Retinal fundus photograph:
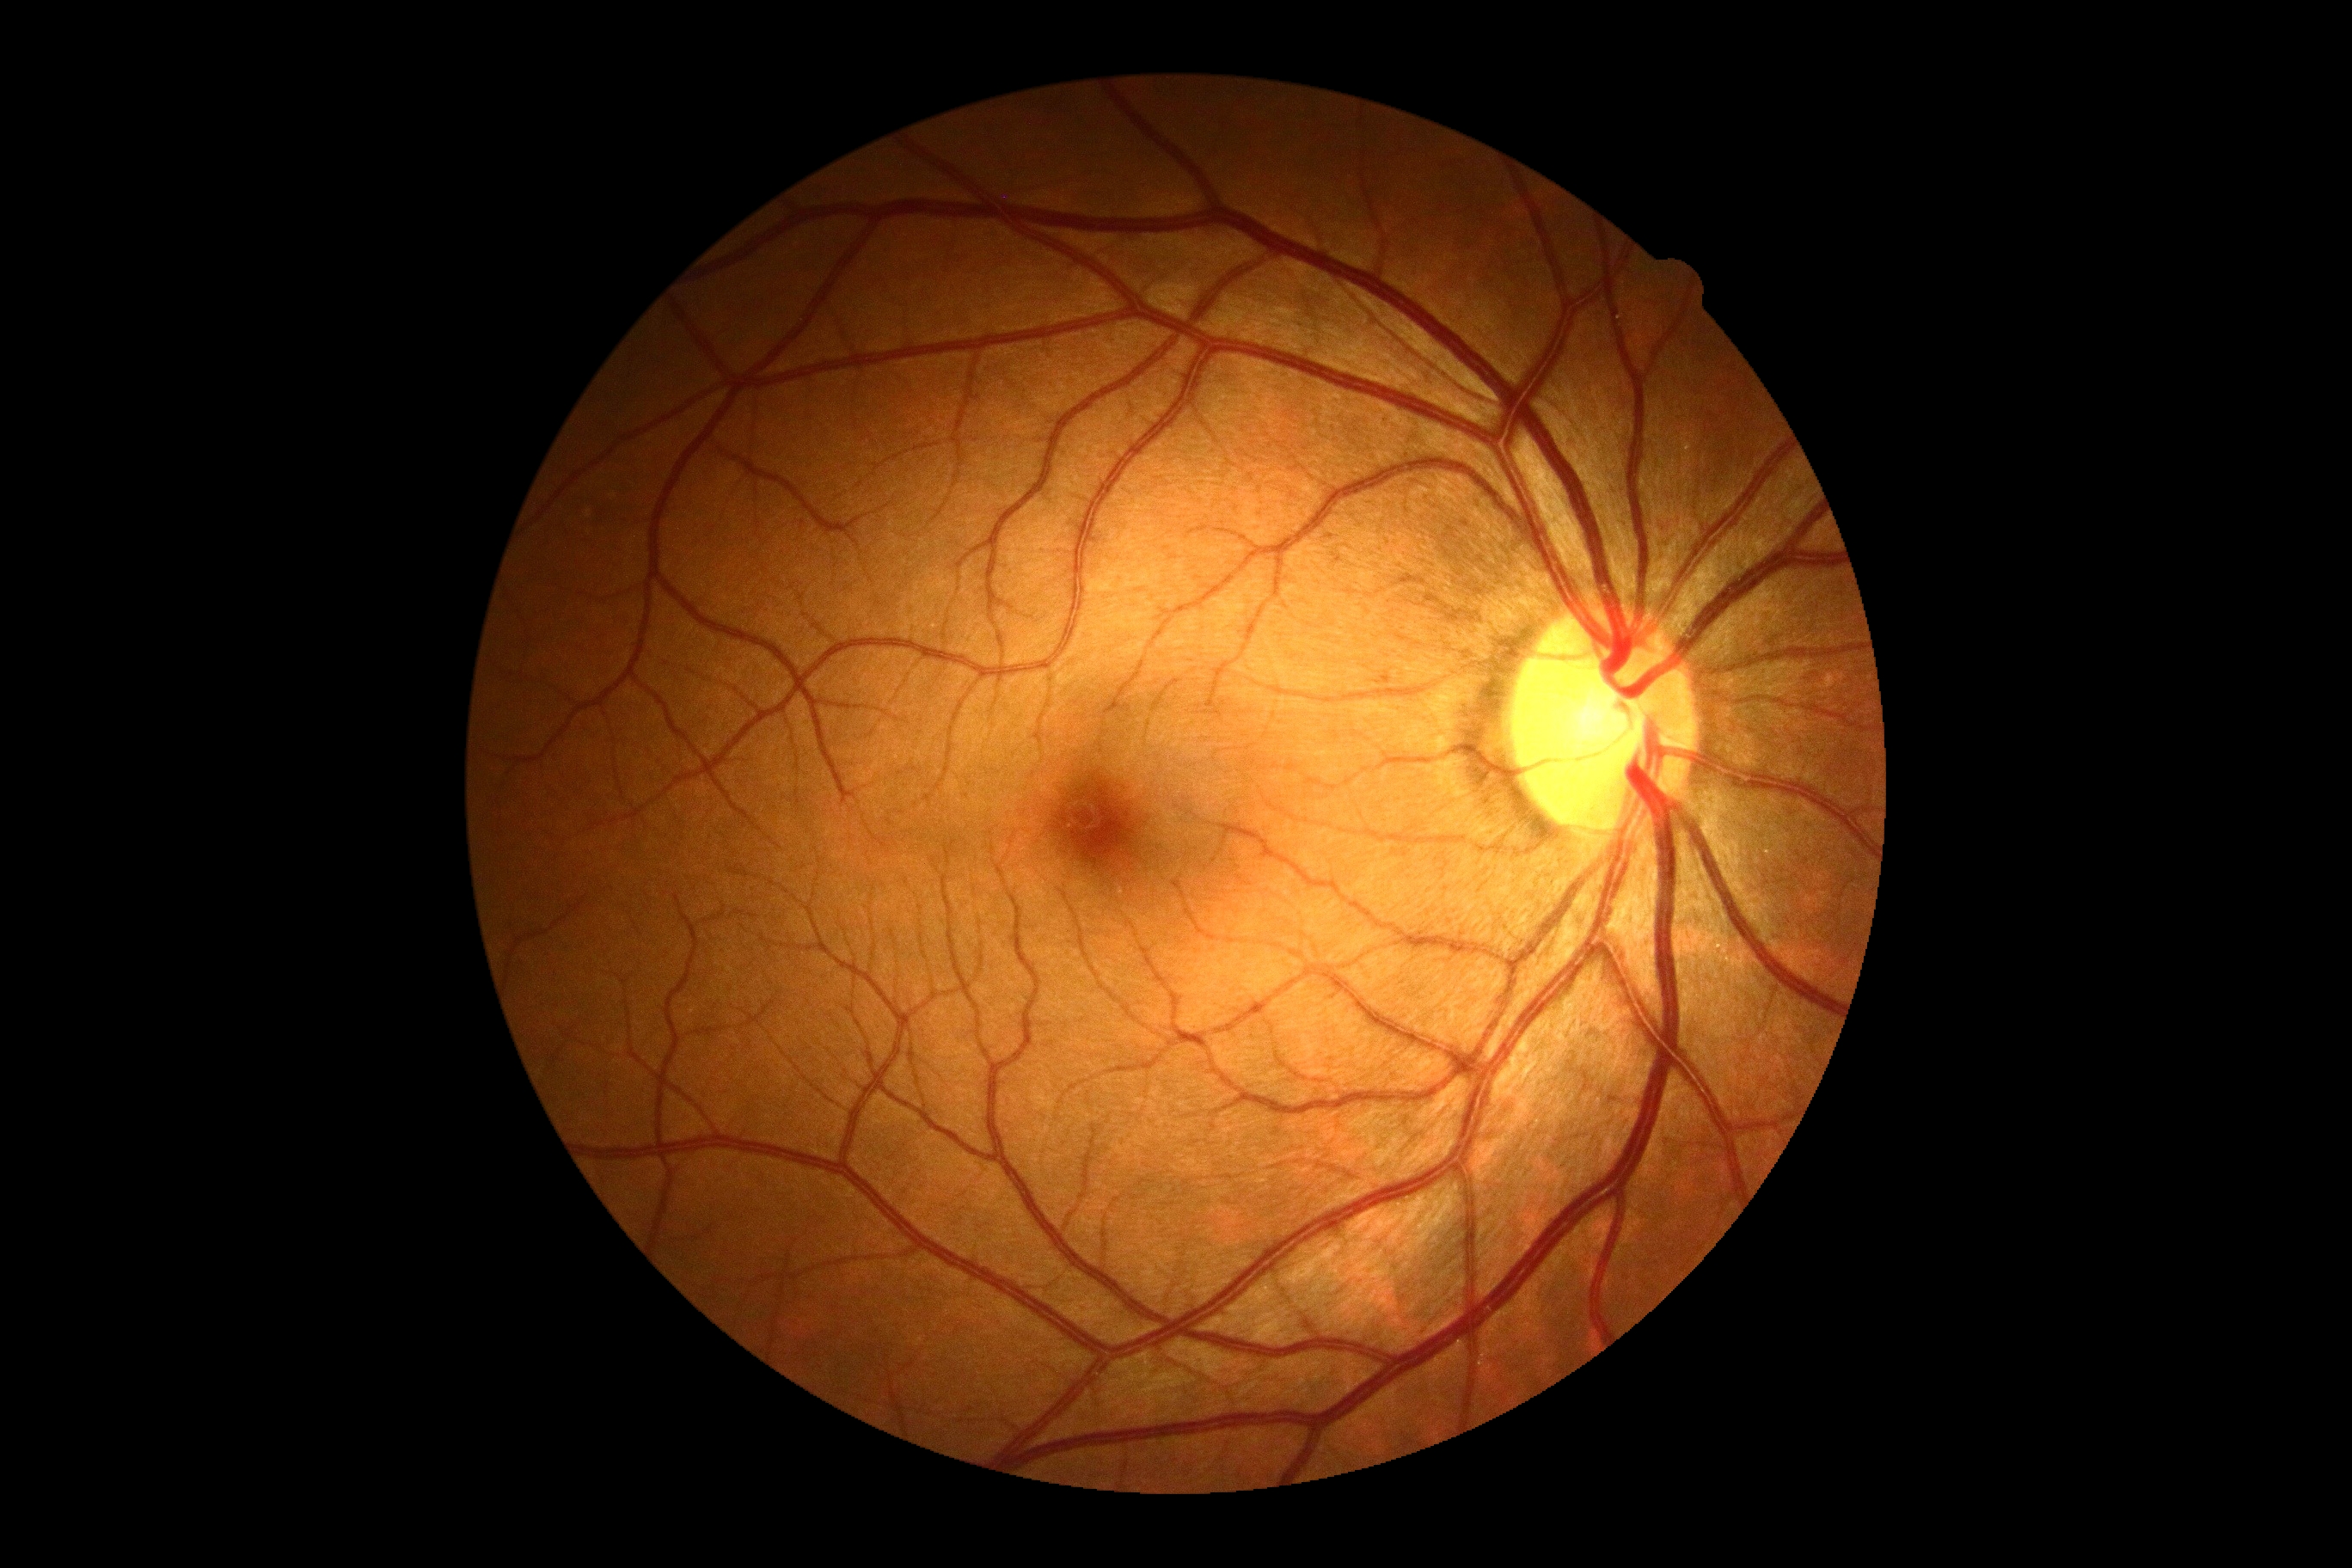
  dr_grade: 0
  dr_impression: no apparent DR